200° field of view, 1924x1556px.
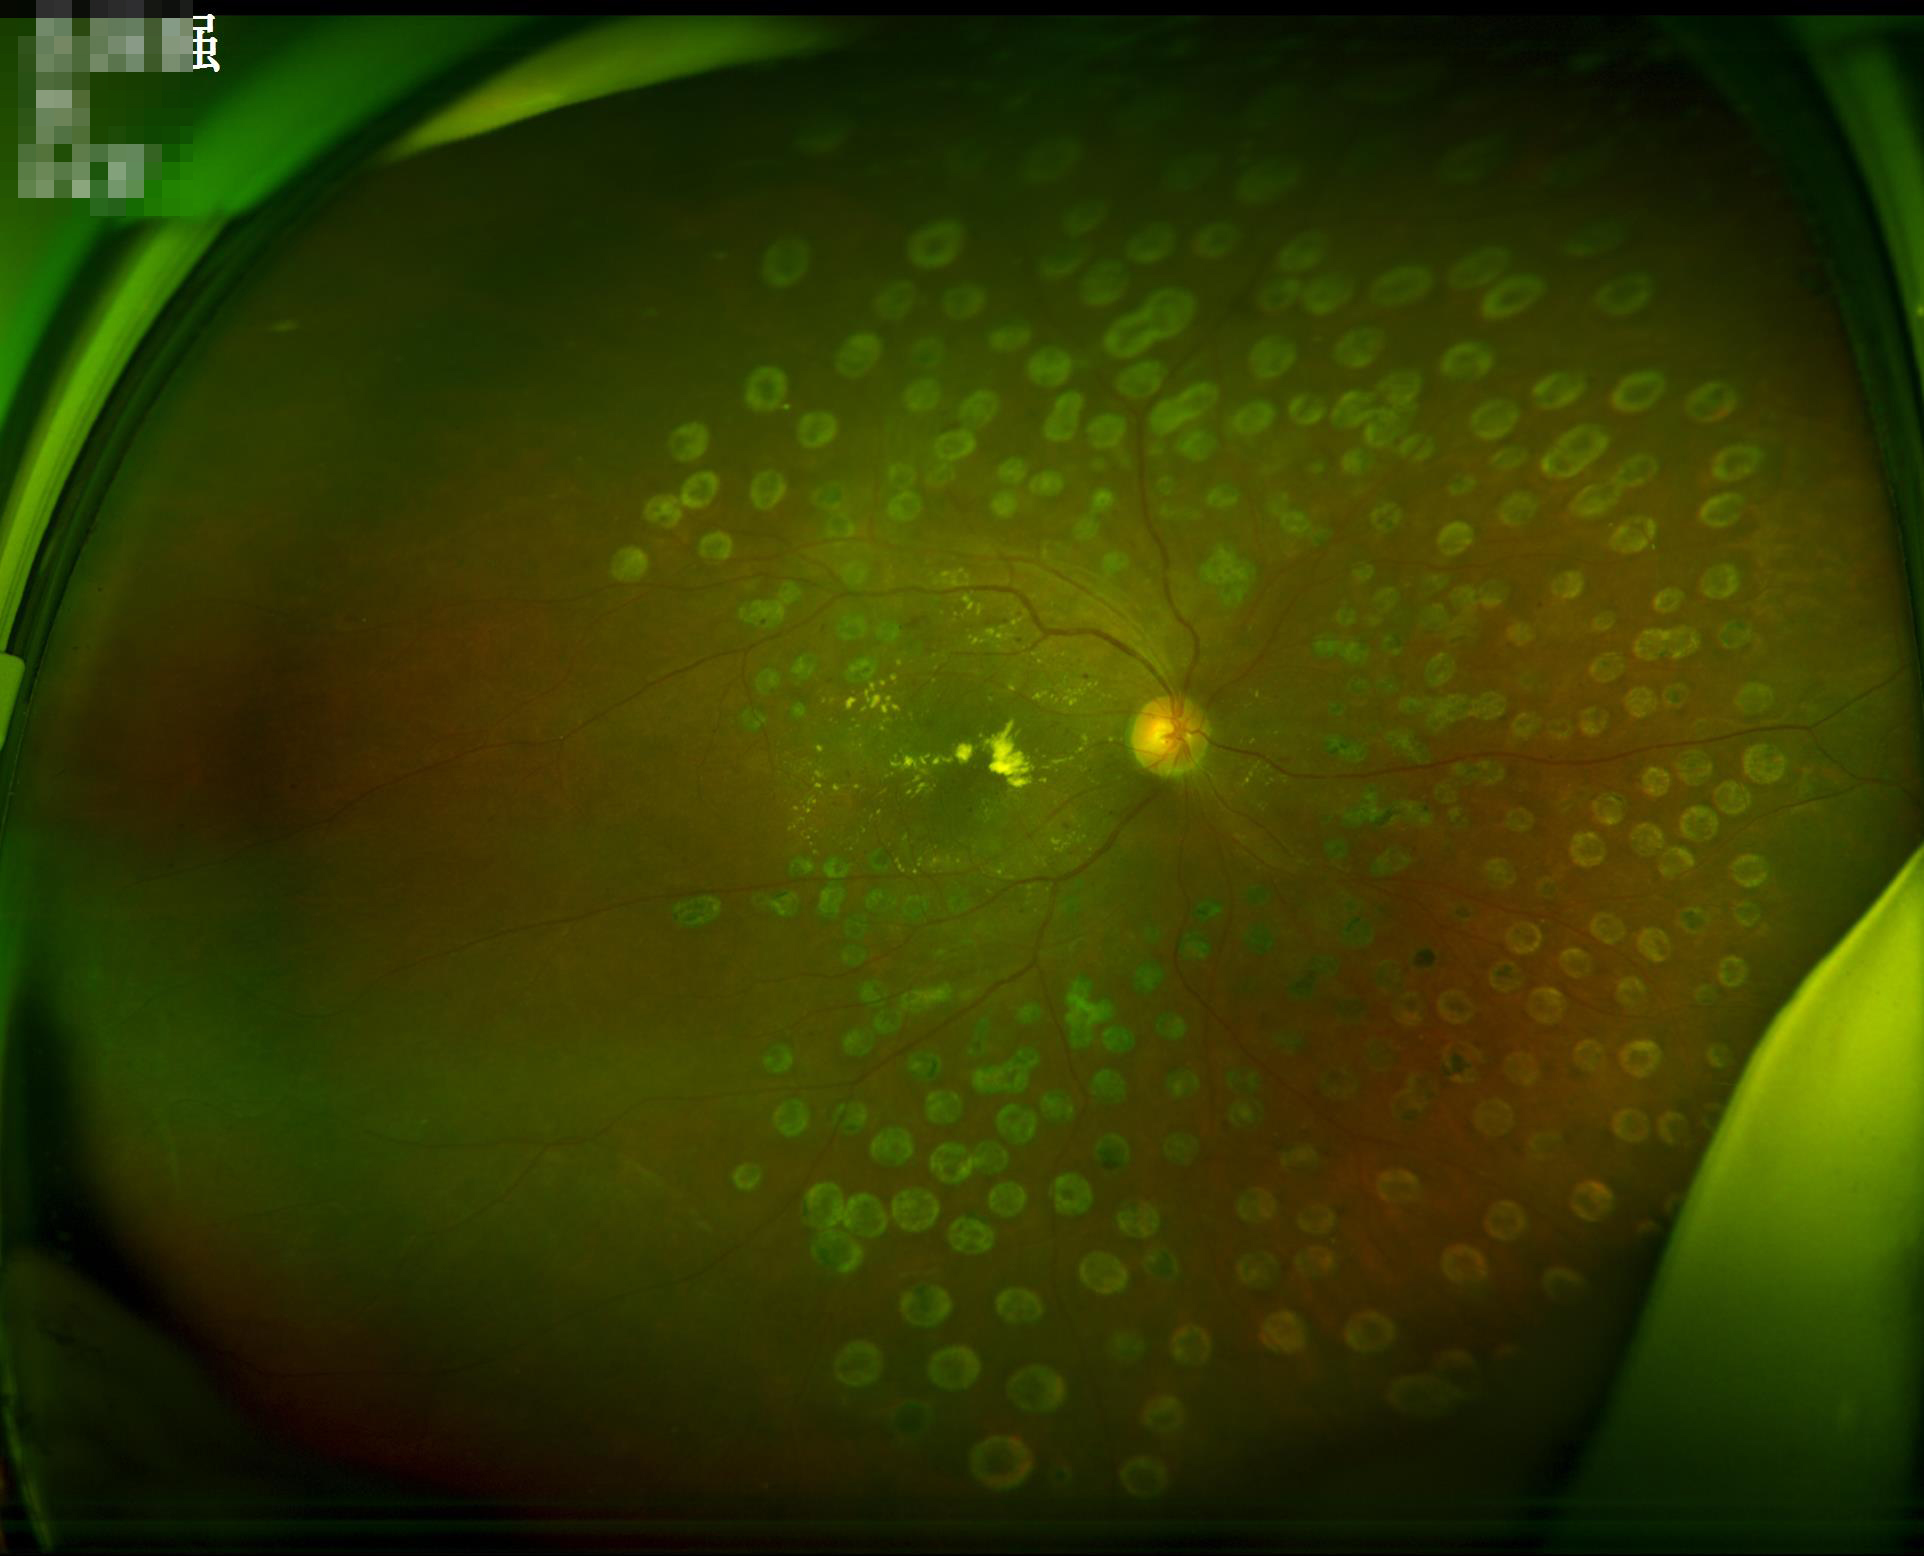
Illumination and color balance are good.
Image is sharp throughout the field.
Vessels and details are readily distinguishable.
Overall quality is good and the image is gradable.